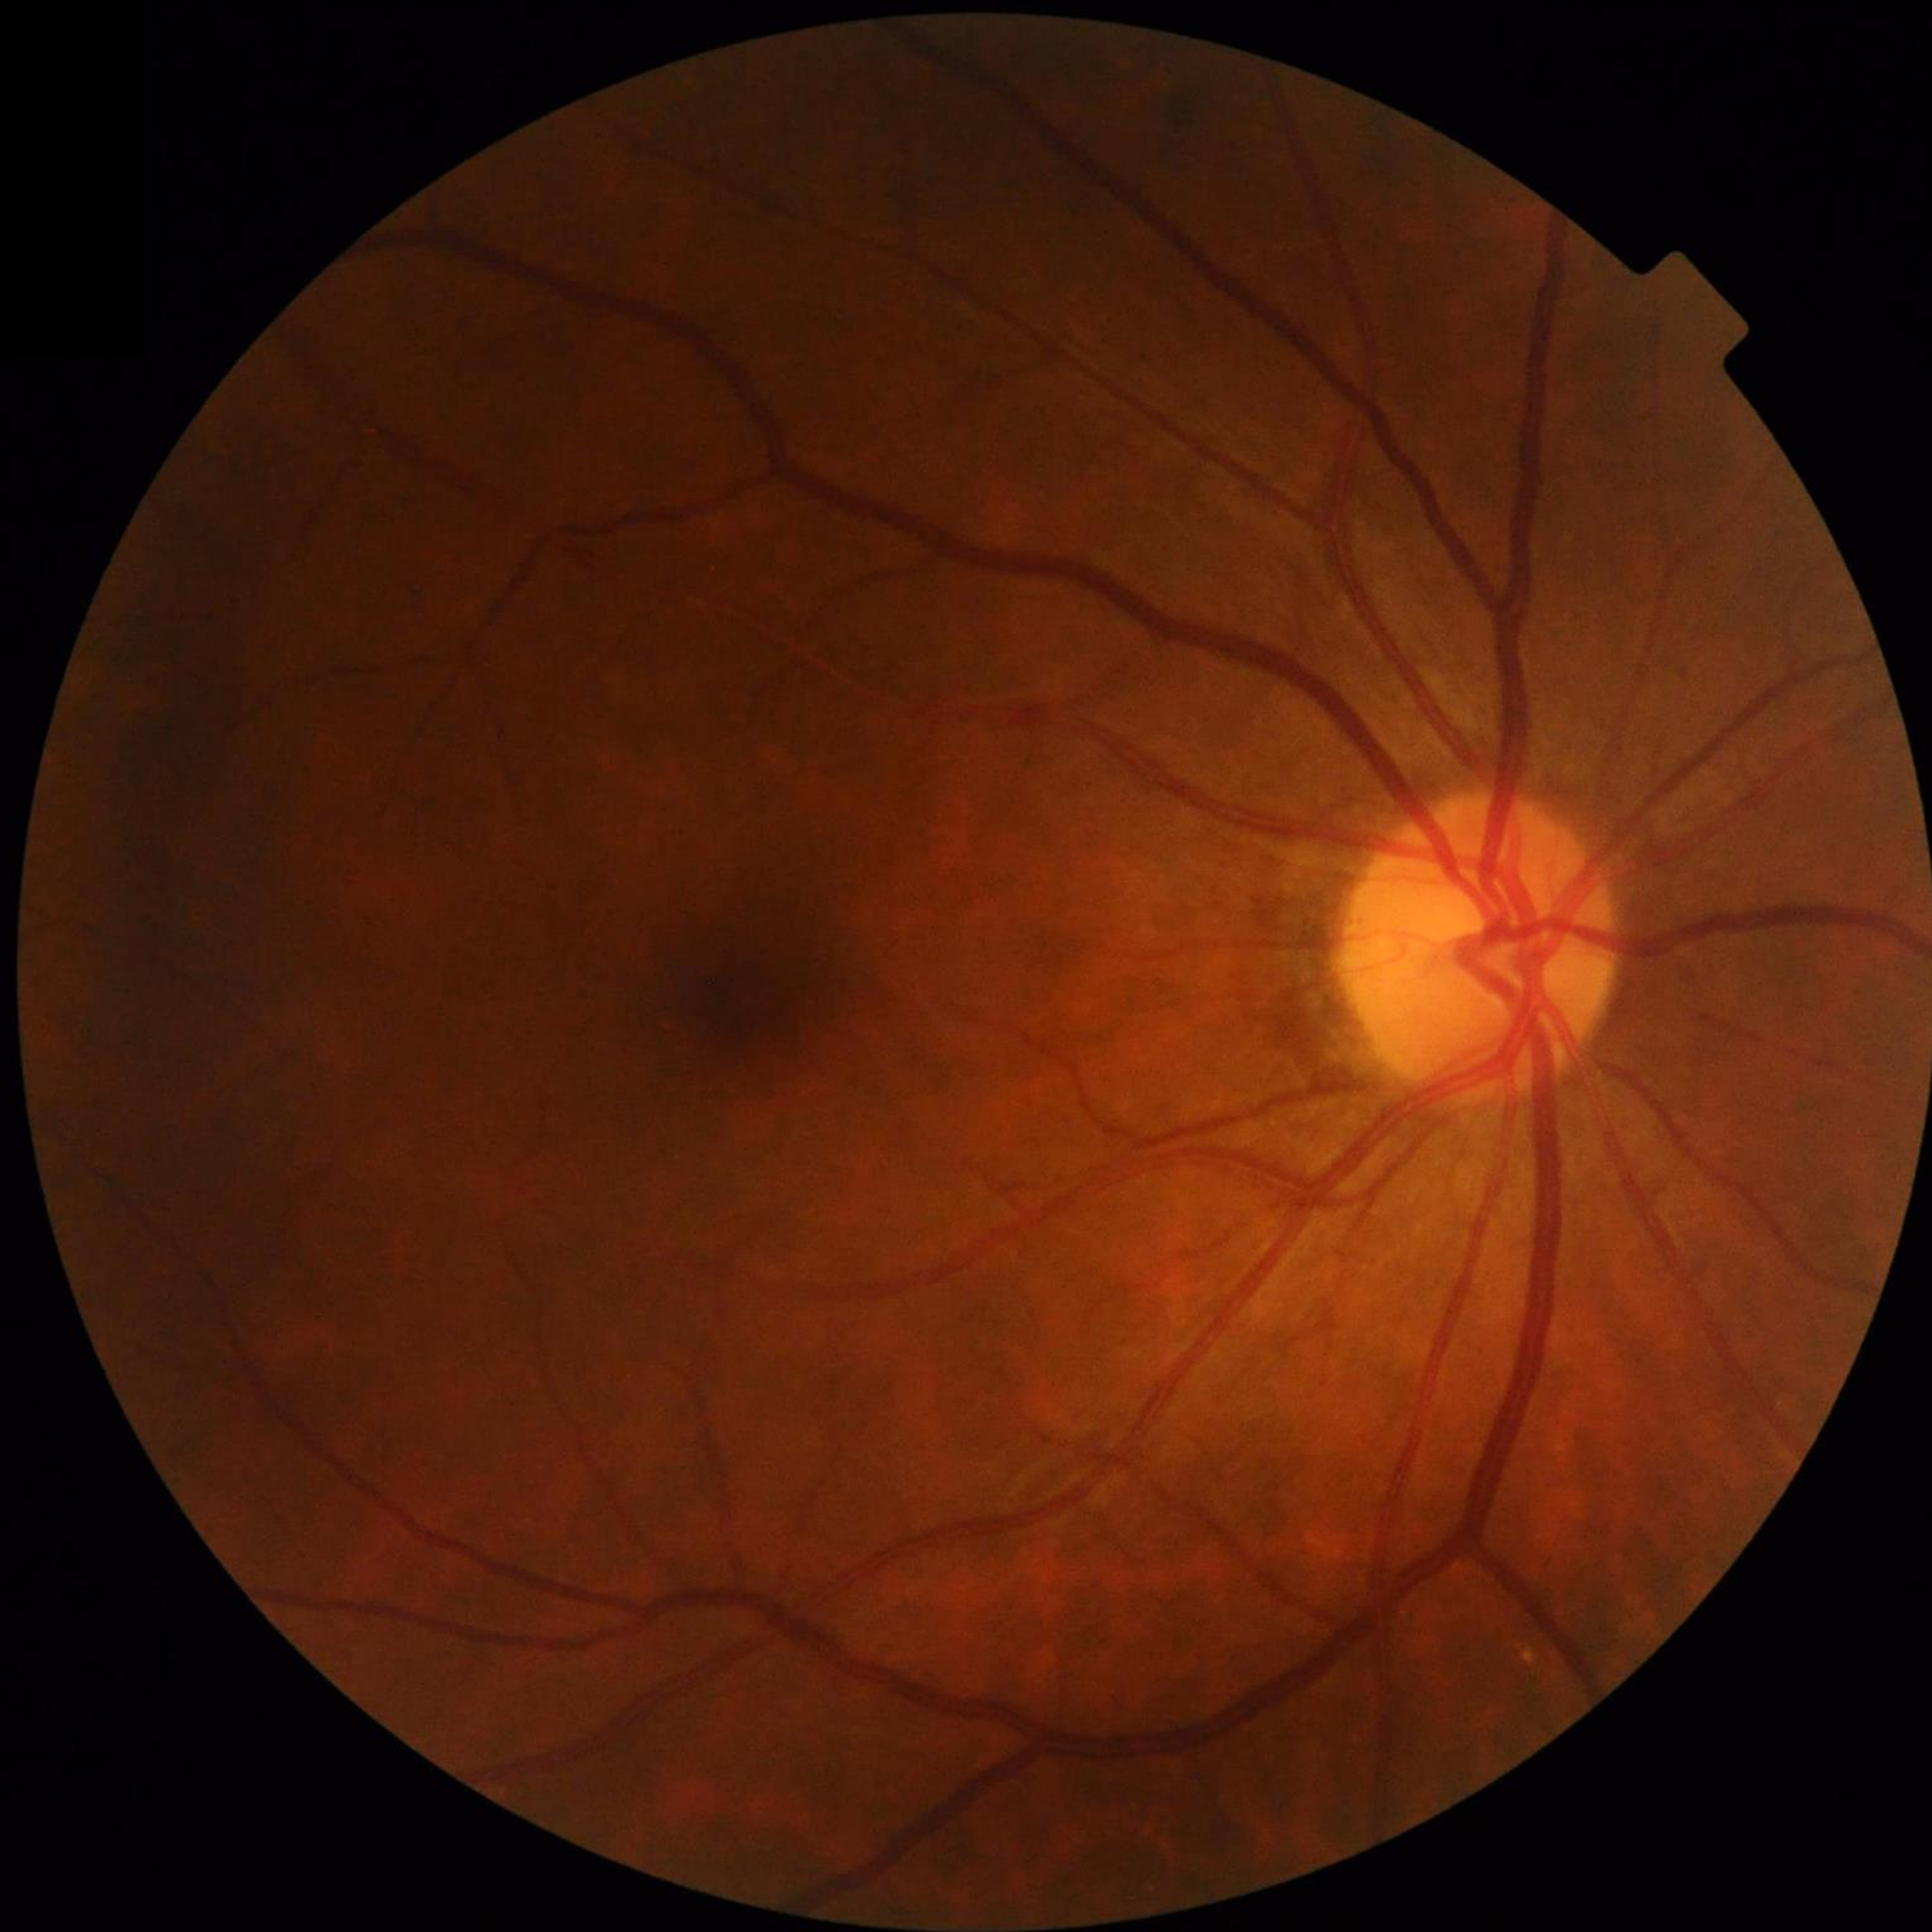 {
  "diagnosis": "no AMD, DR, or glaucoma",
  "image_quality": "no blur, illumination and color satisfactory, contrast adequate"
}